Wide-field retinal mosaic image: 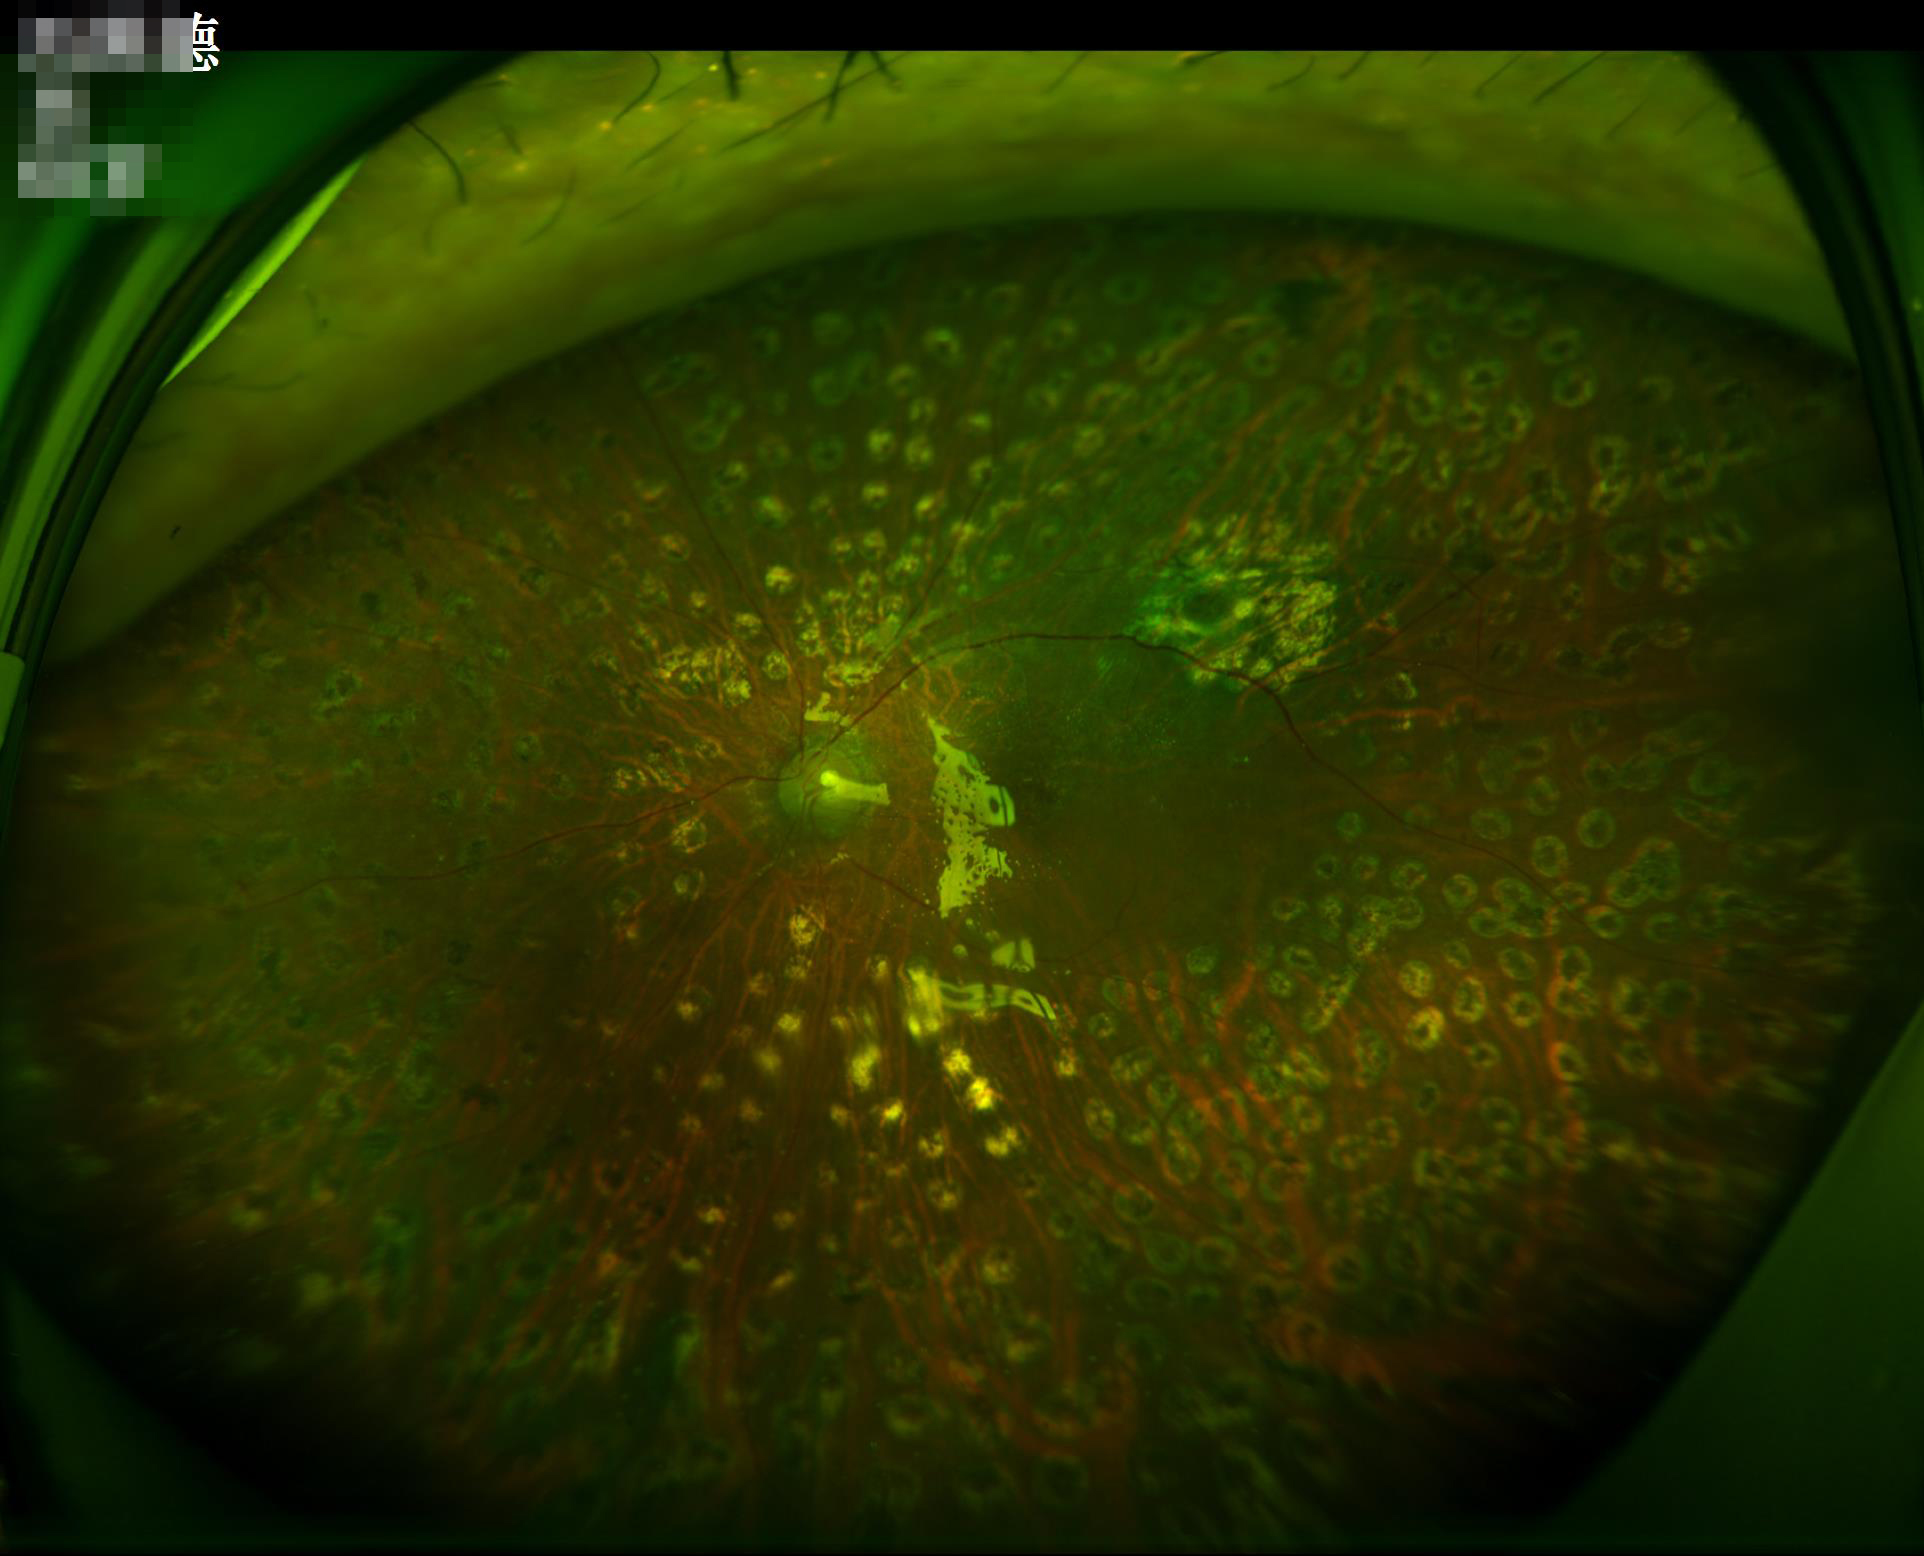

Poor illumination with uneven exposure. Image is sharp throughout the field. Overall image quality is good.